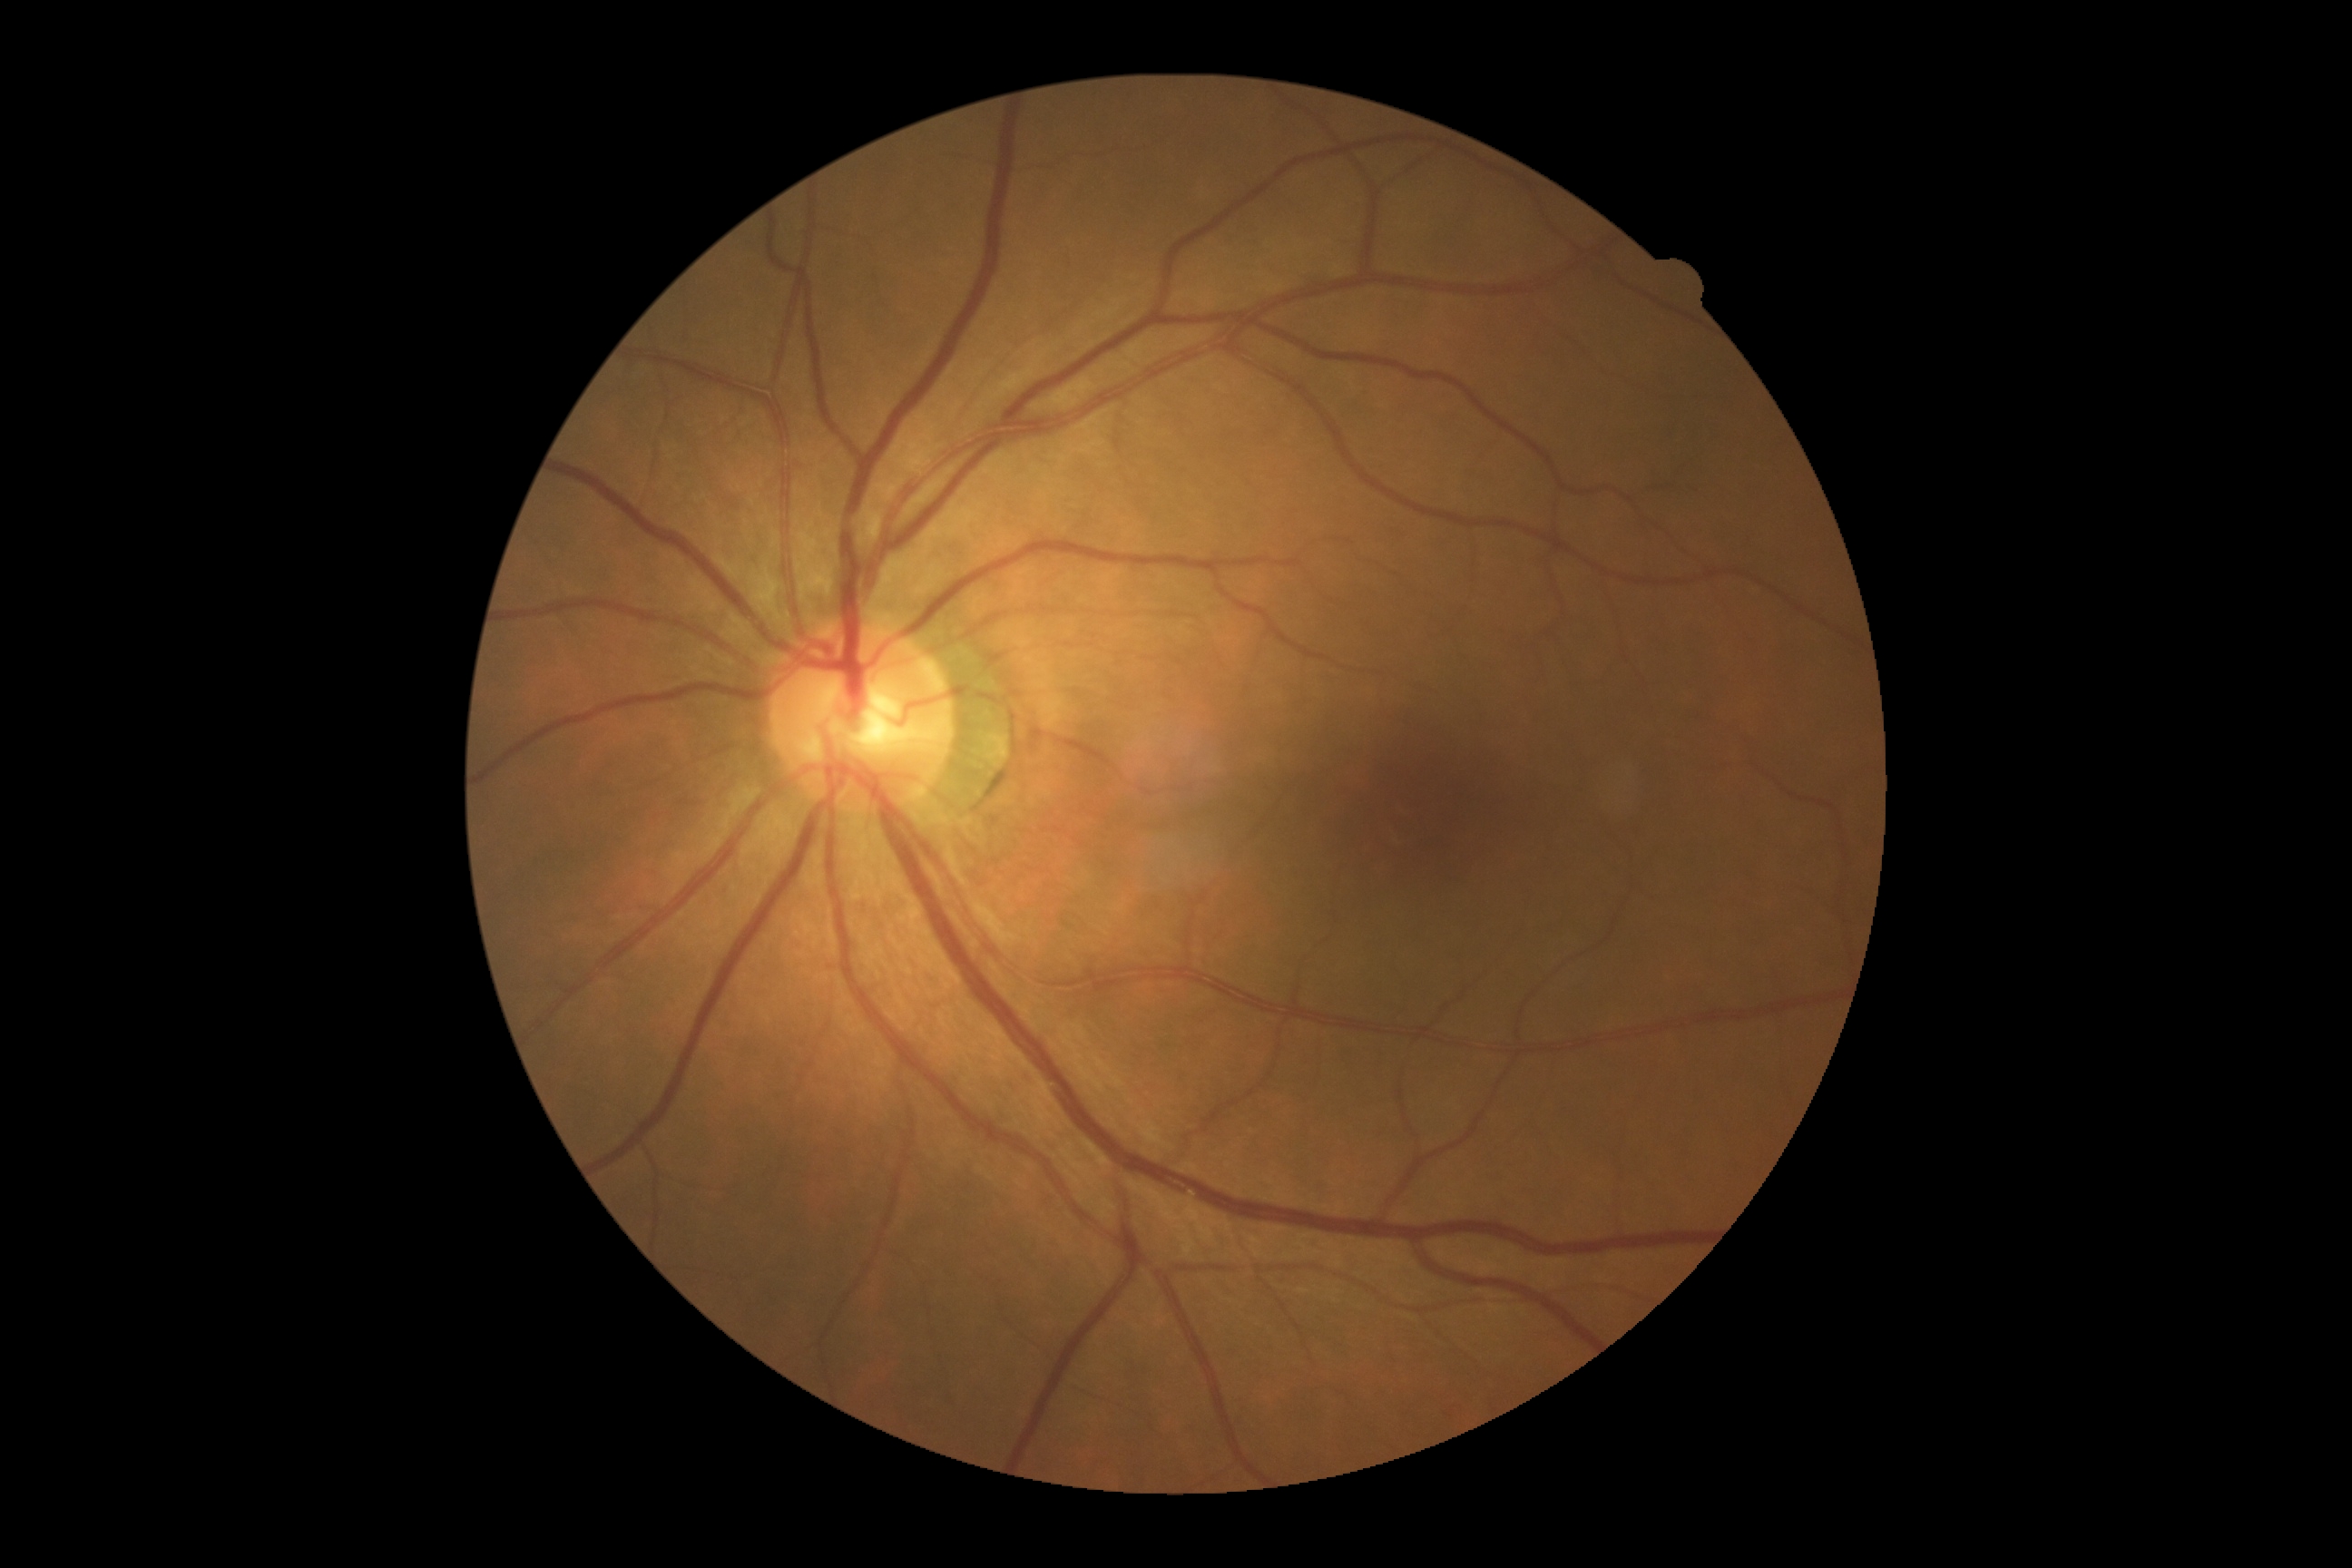
retinopathy@grade 0 — no visible signs of diabetic retinopathy; DR impression@no apparent DR.